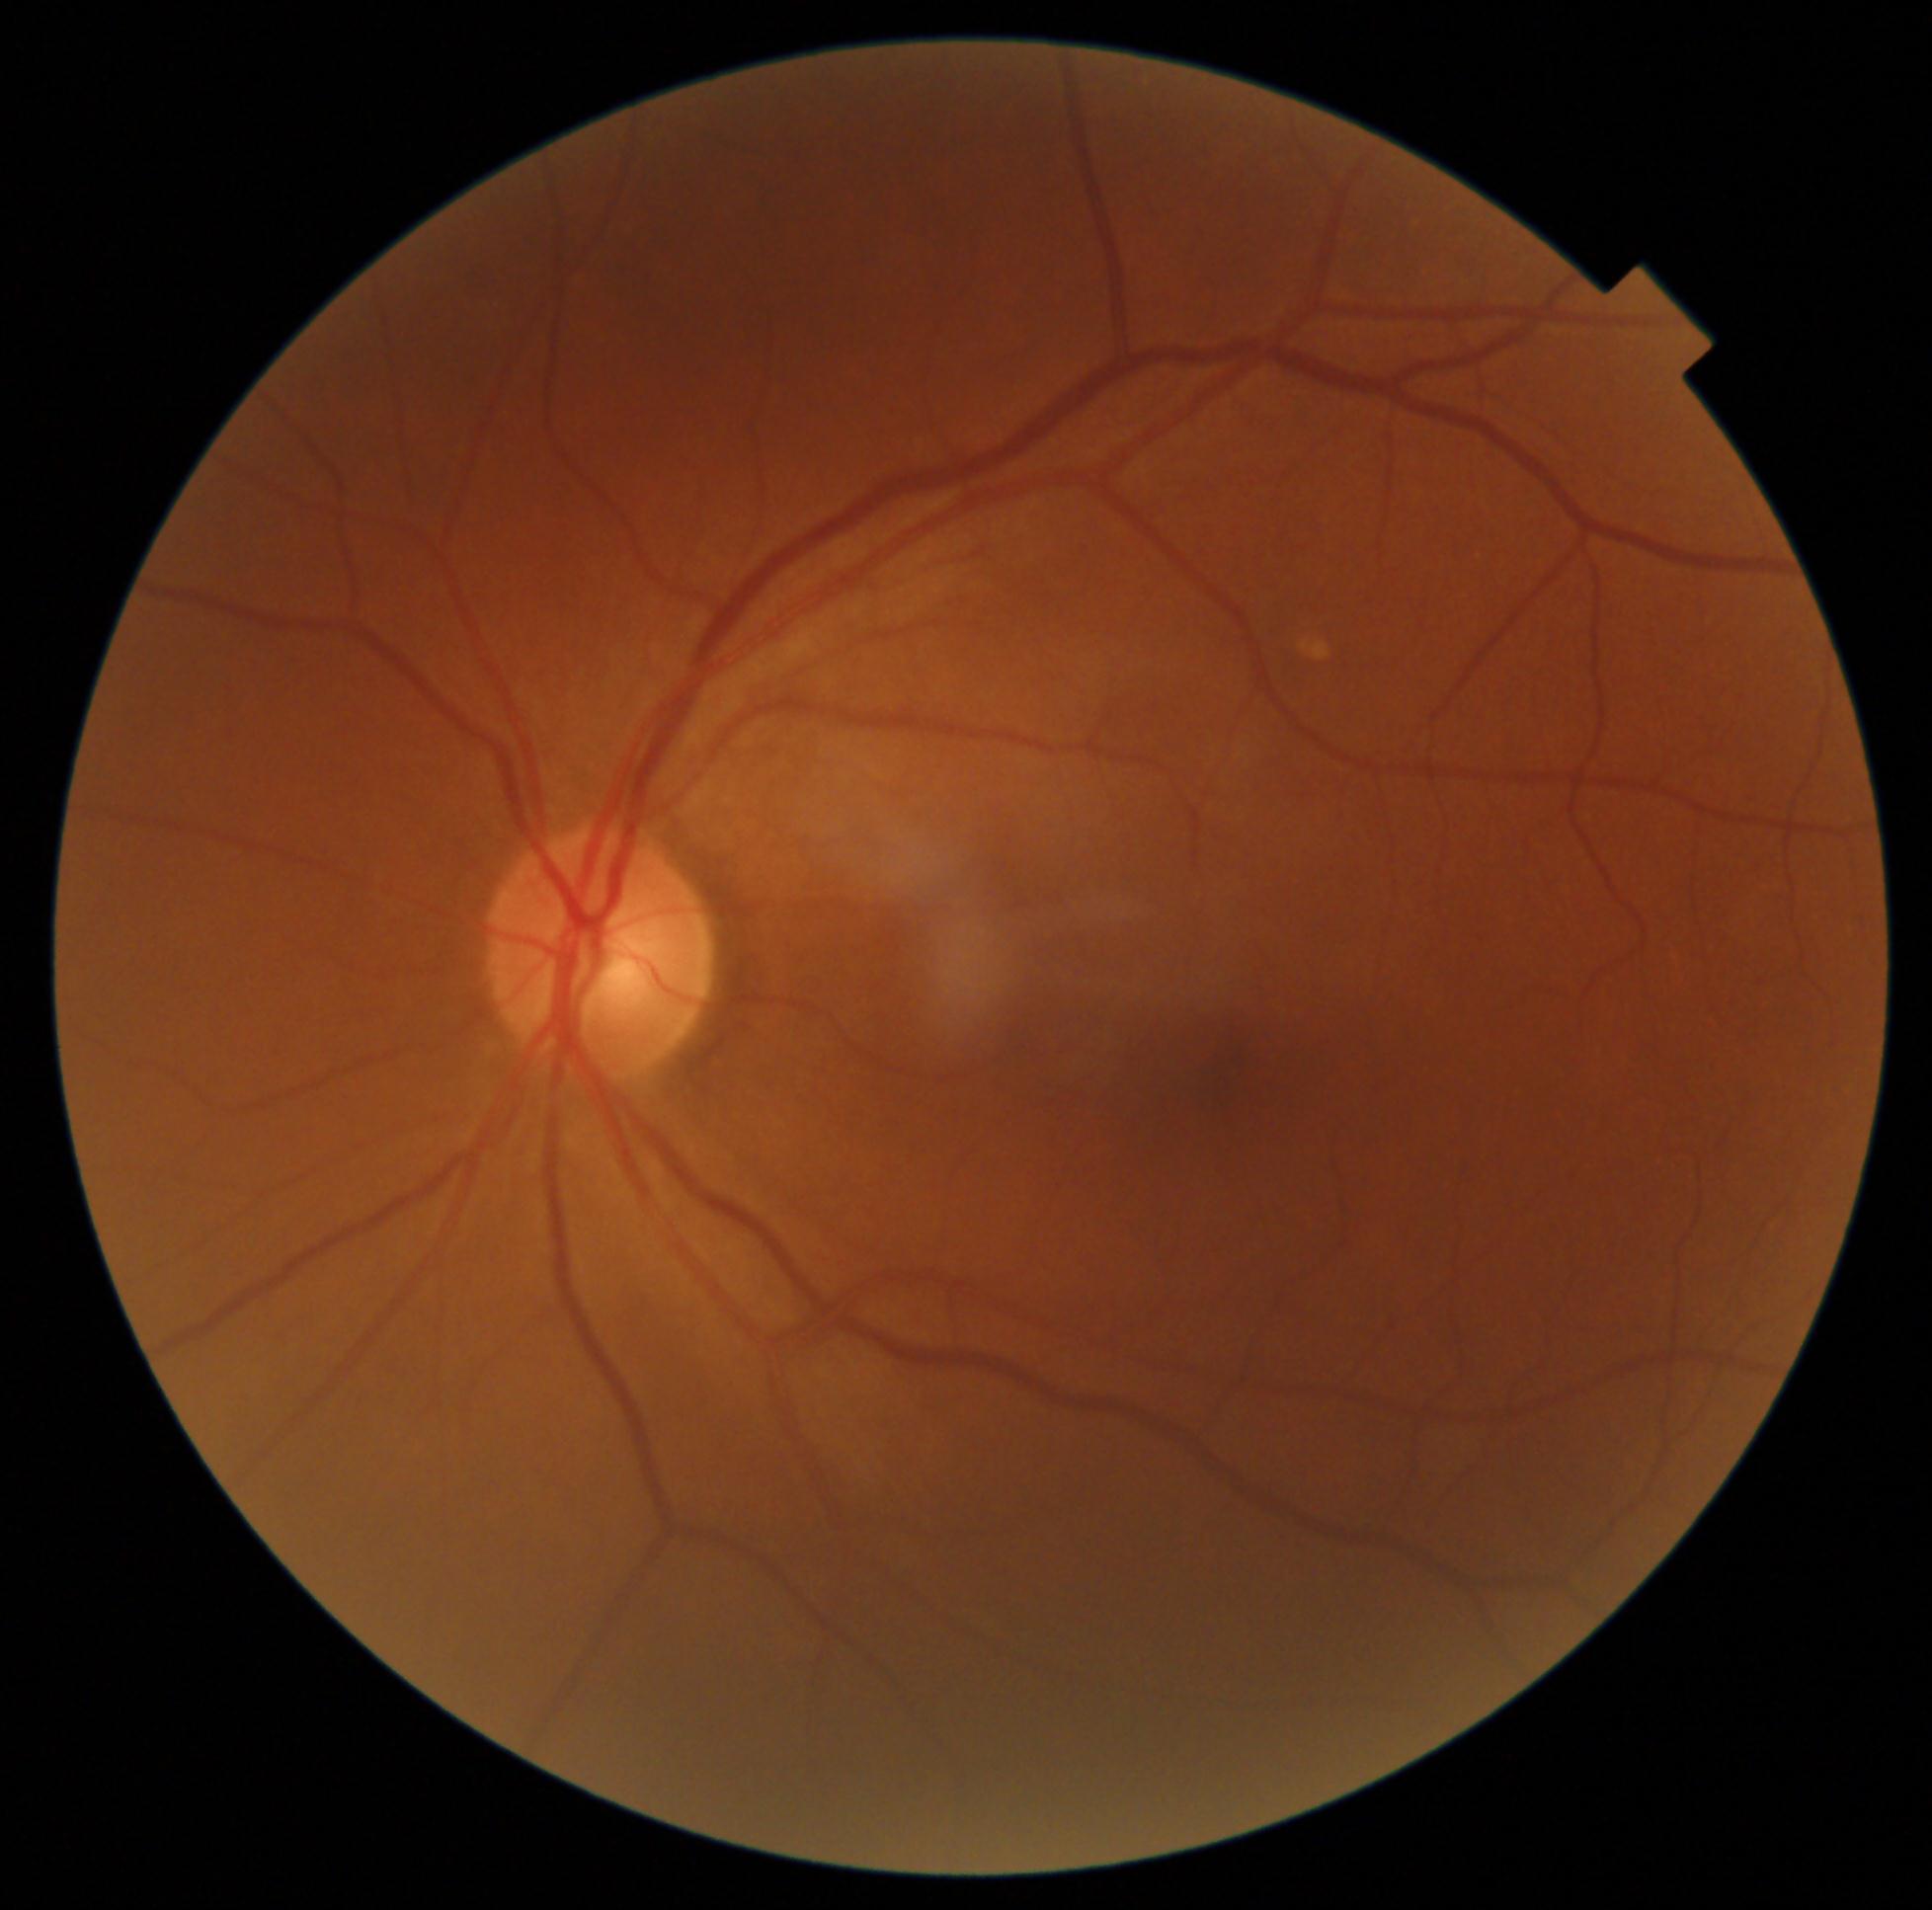
diabetic retinopathy@grade 0 (no apparent retinopathy).